FOV: 50 degrees: 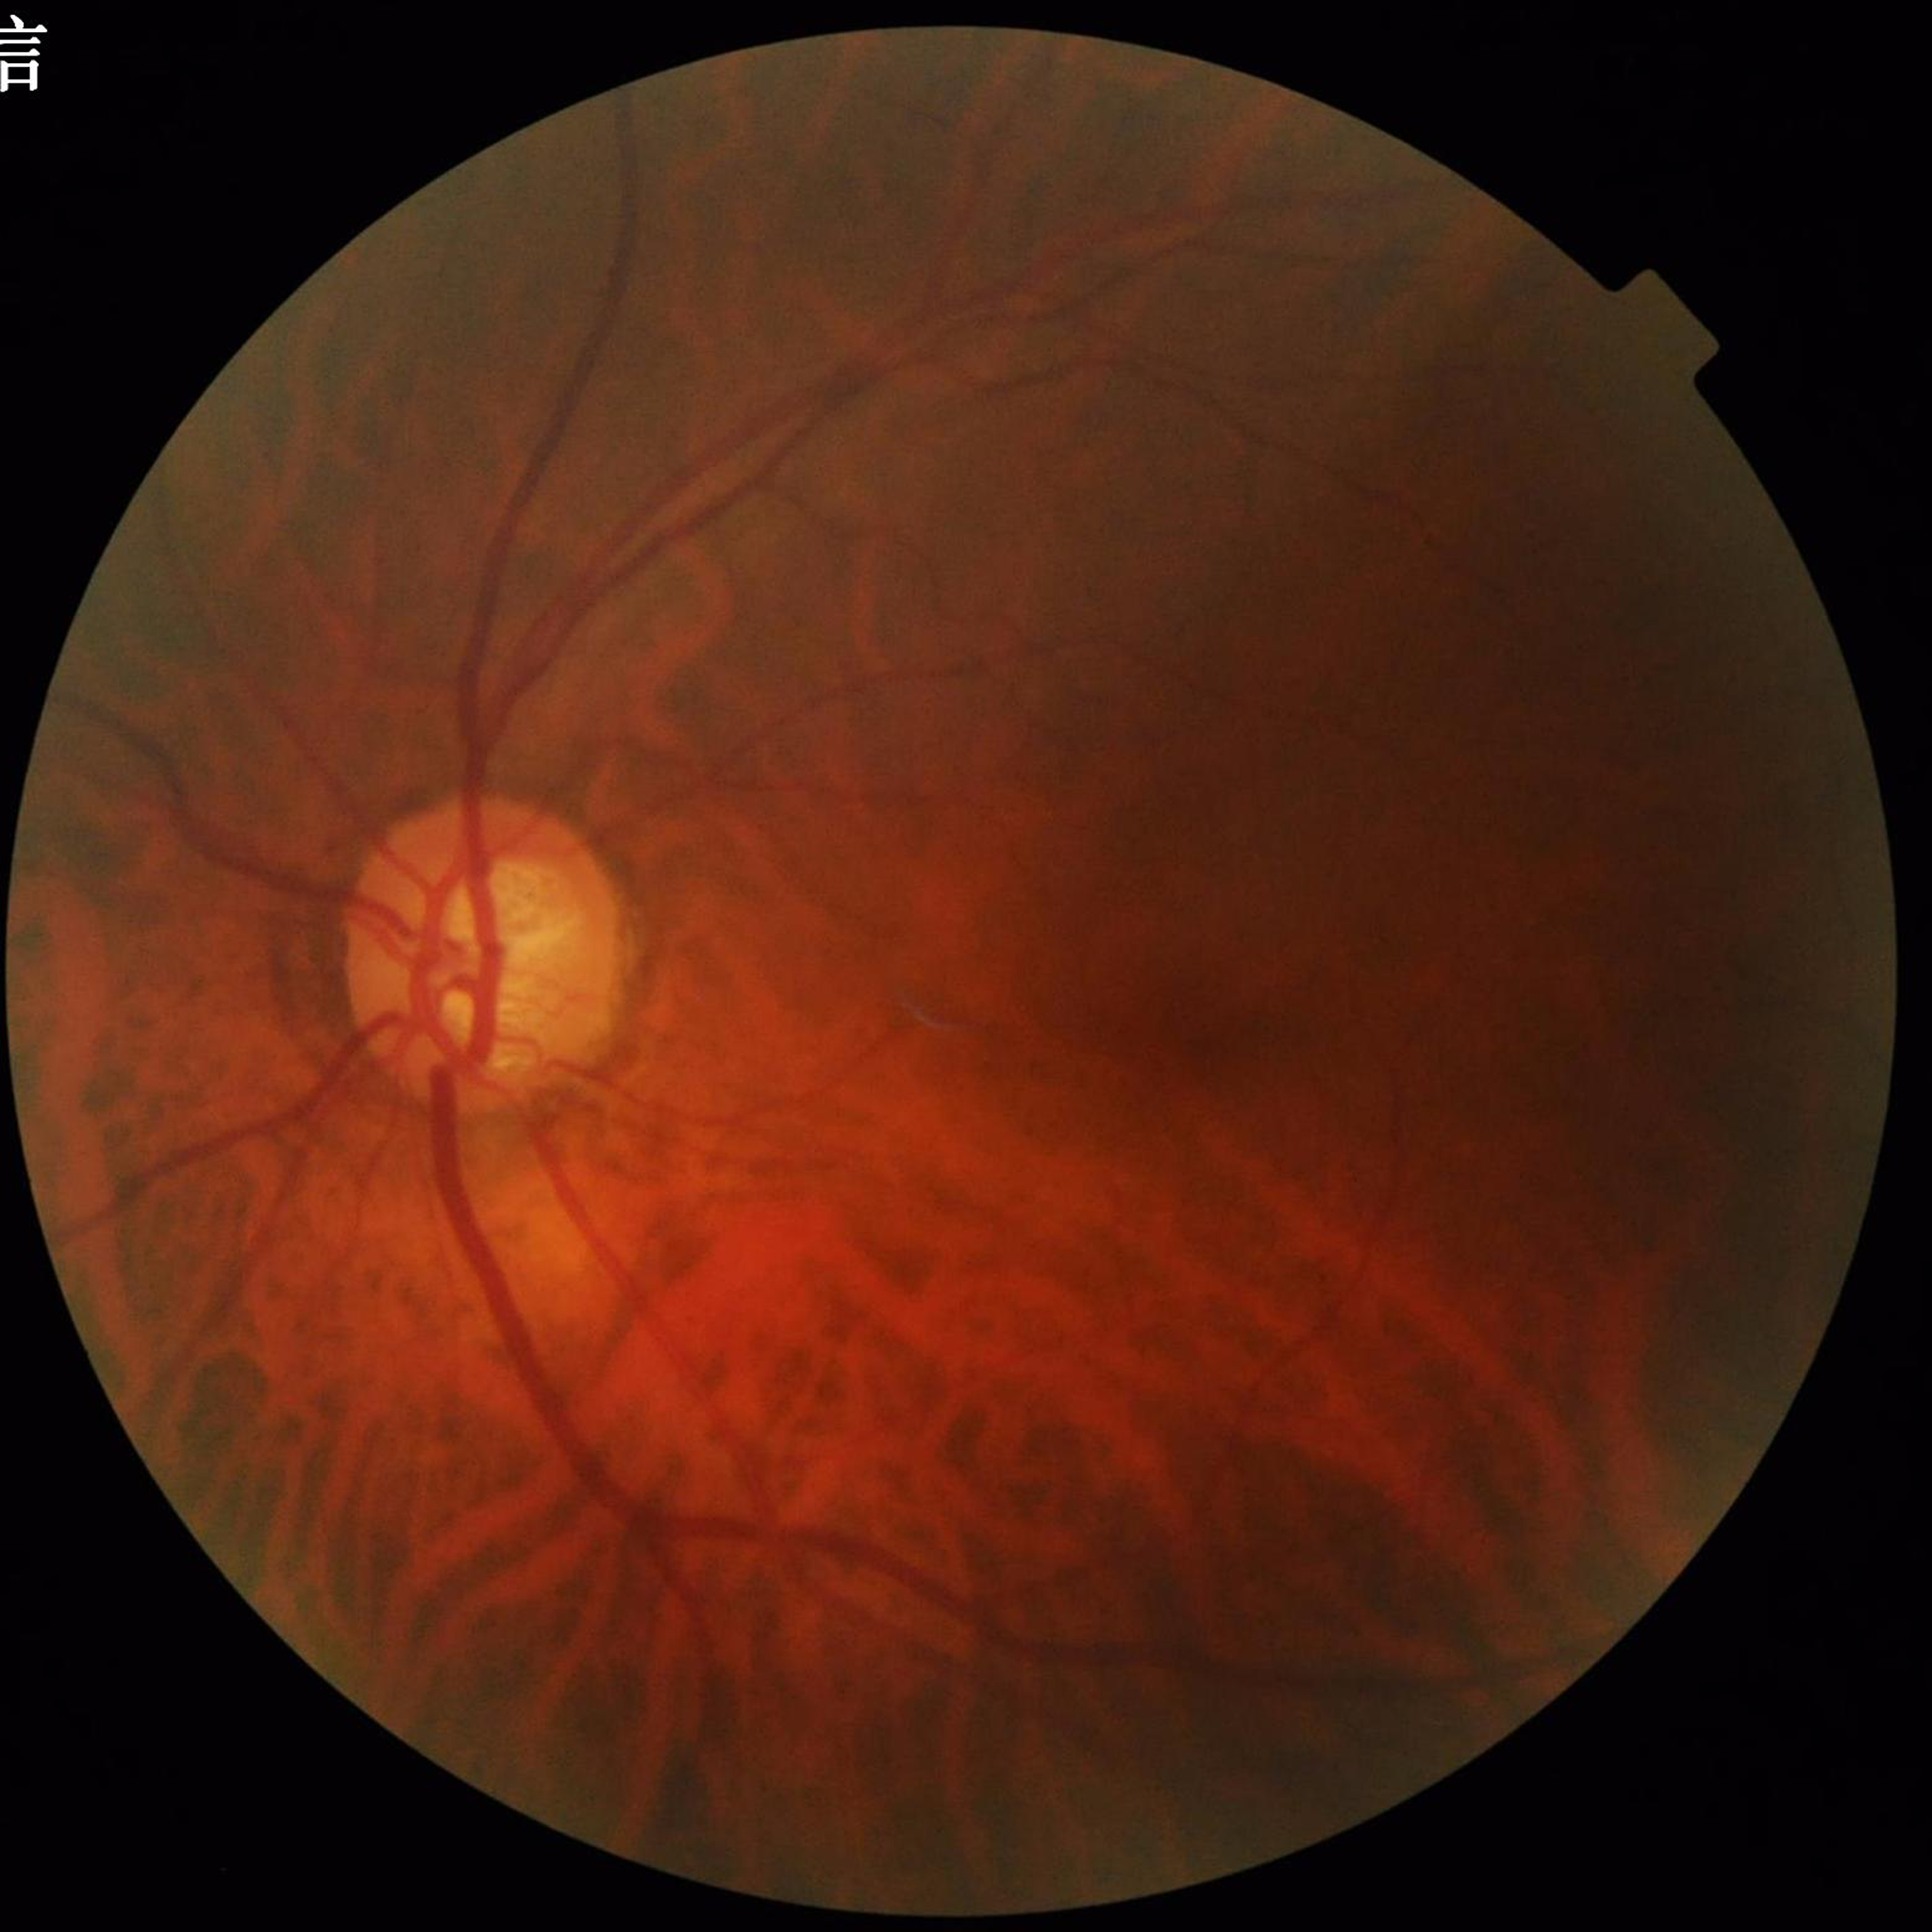

Patient diagnosed with glaucoma.